Color fundus image:
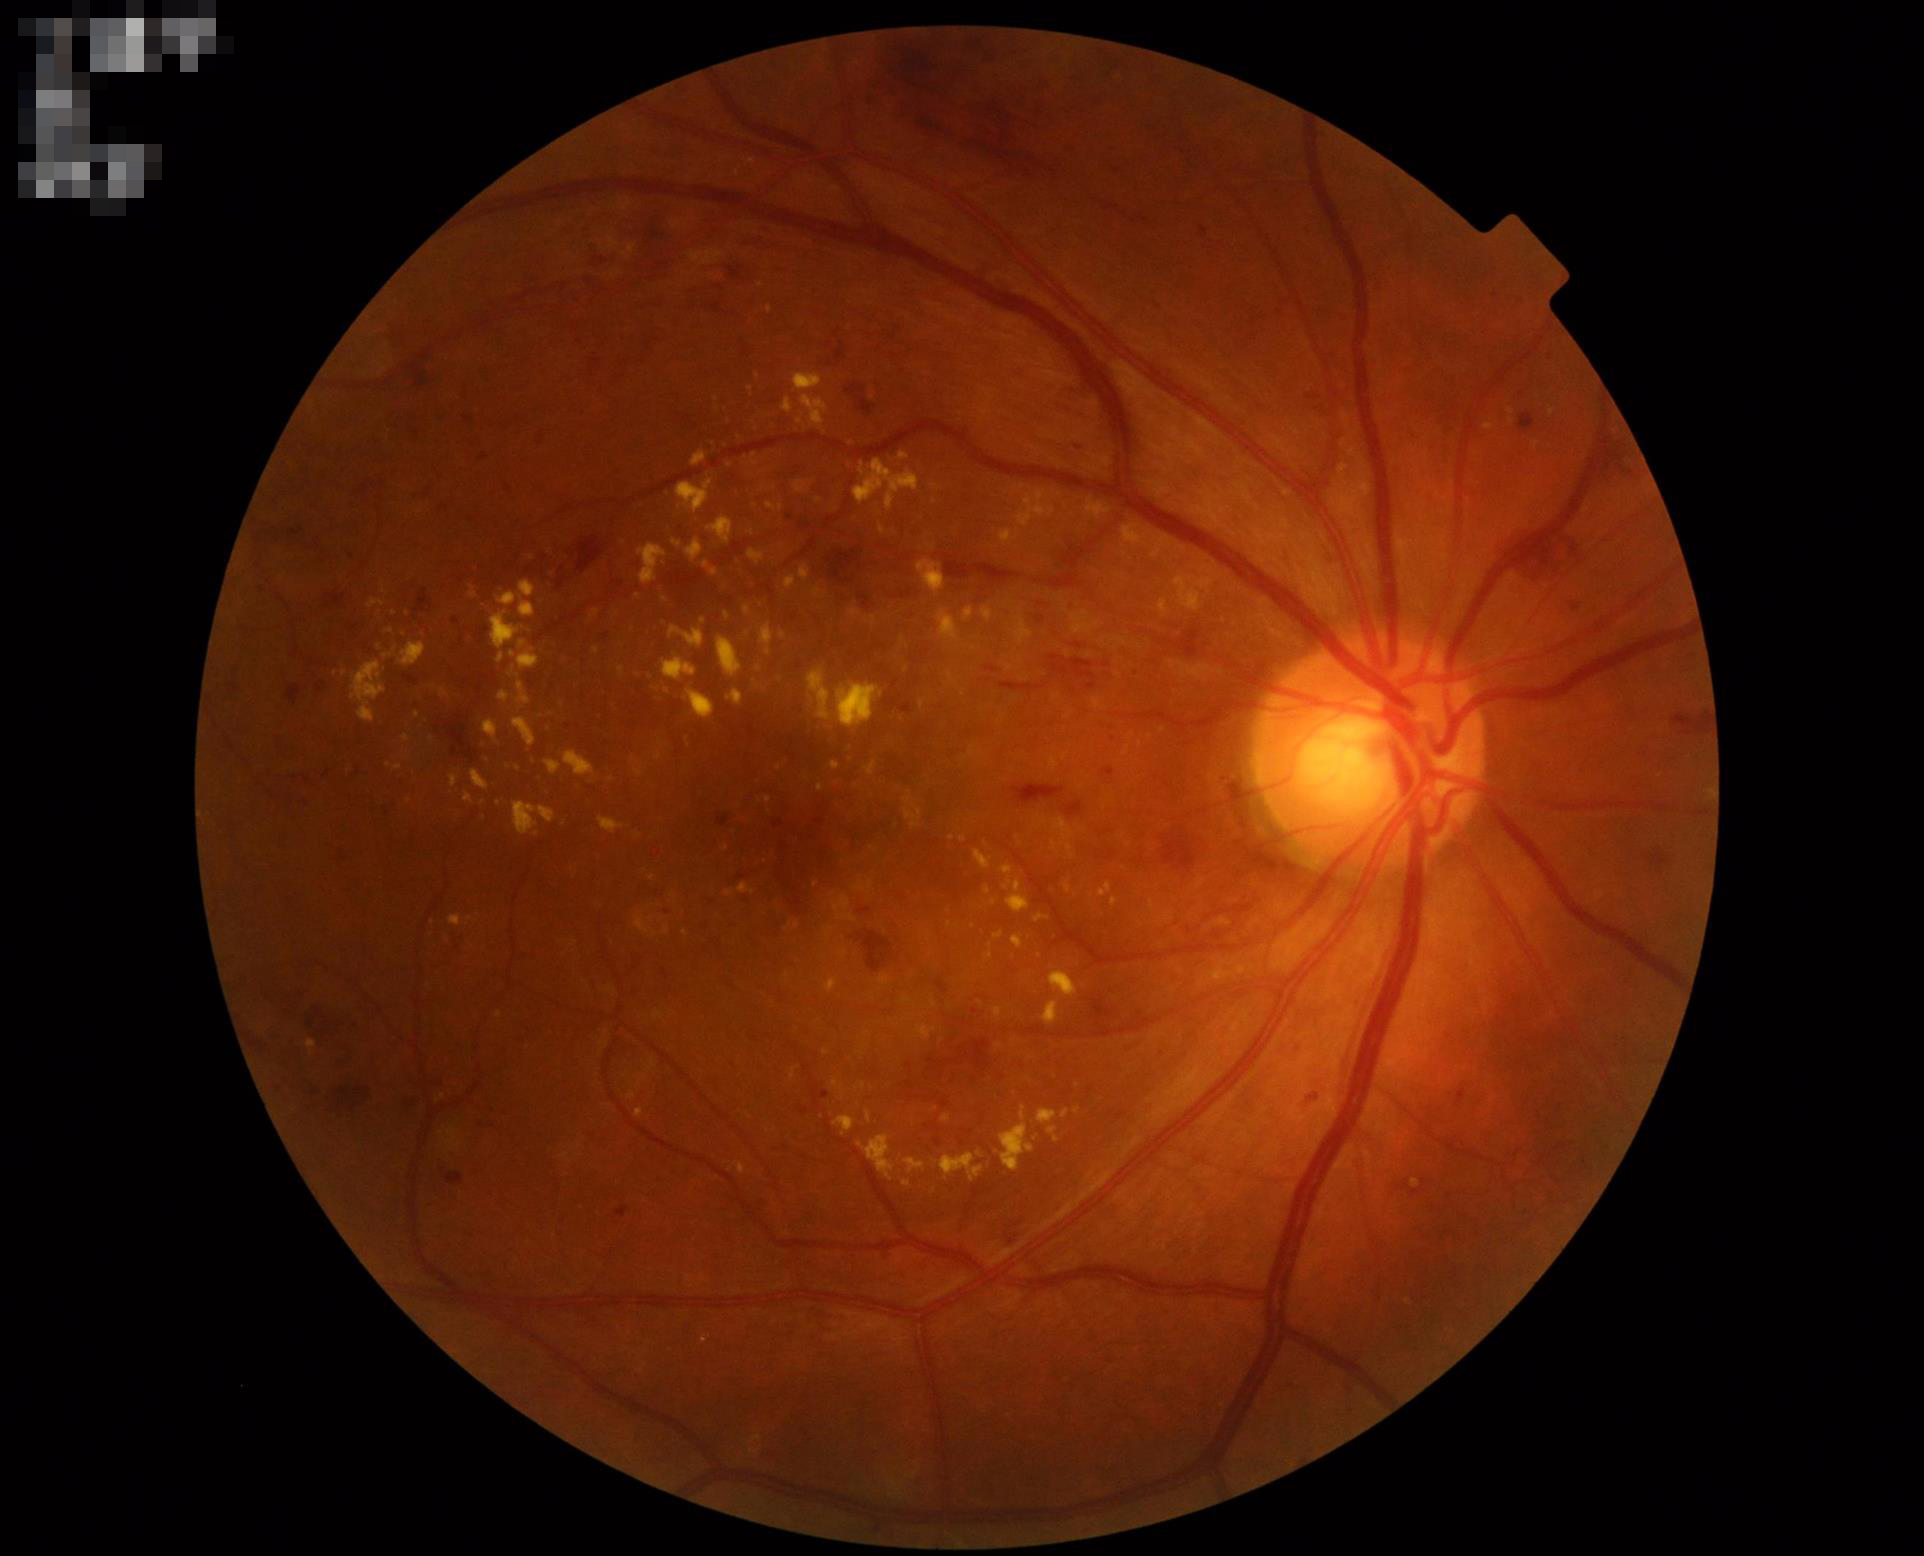

No noticeable blur.
Acceptable image quality.
Illumination is even.